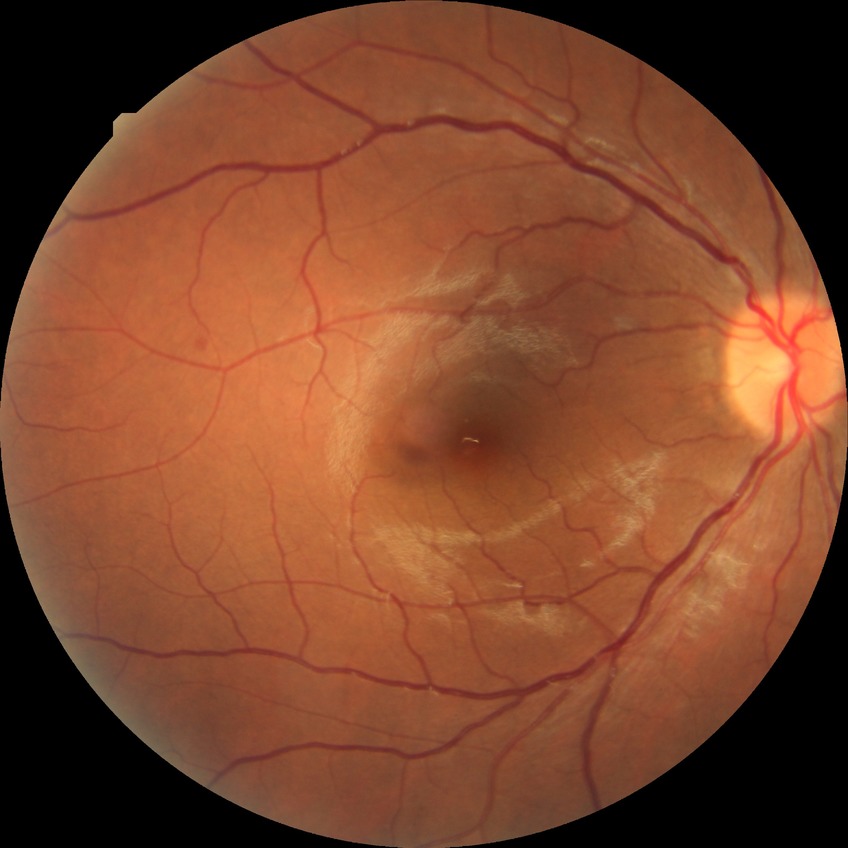

Diabetic retinopathy severity: simple diabetic retinopathy.